Modified Davis grading:
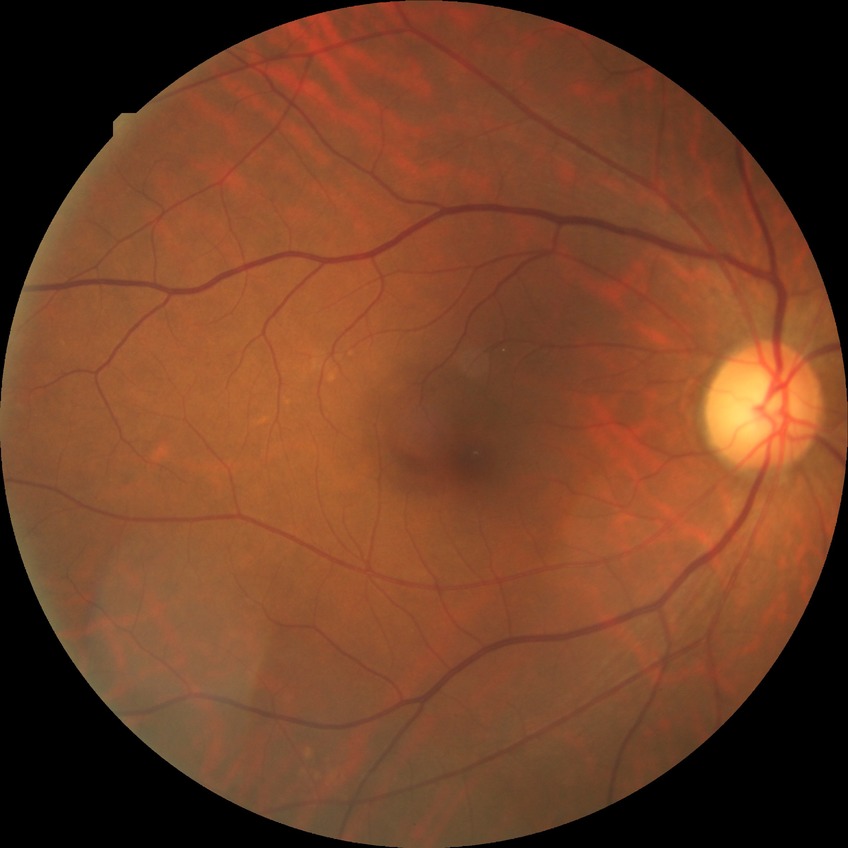

Diabetic retinopathy (DR) is no diabetic retinopathy (NDR).